Fundus photo.
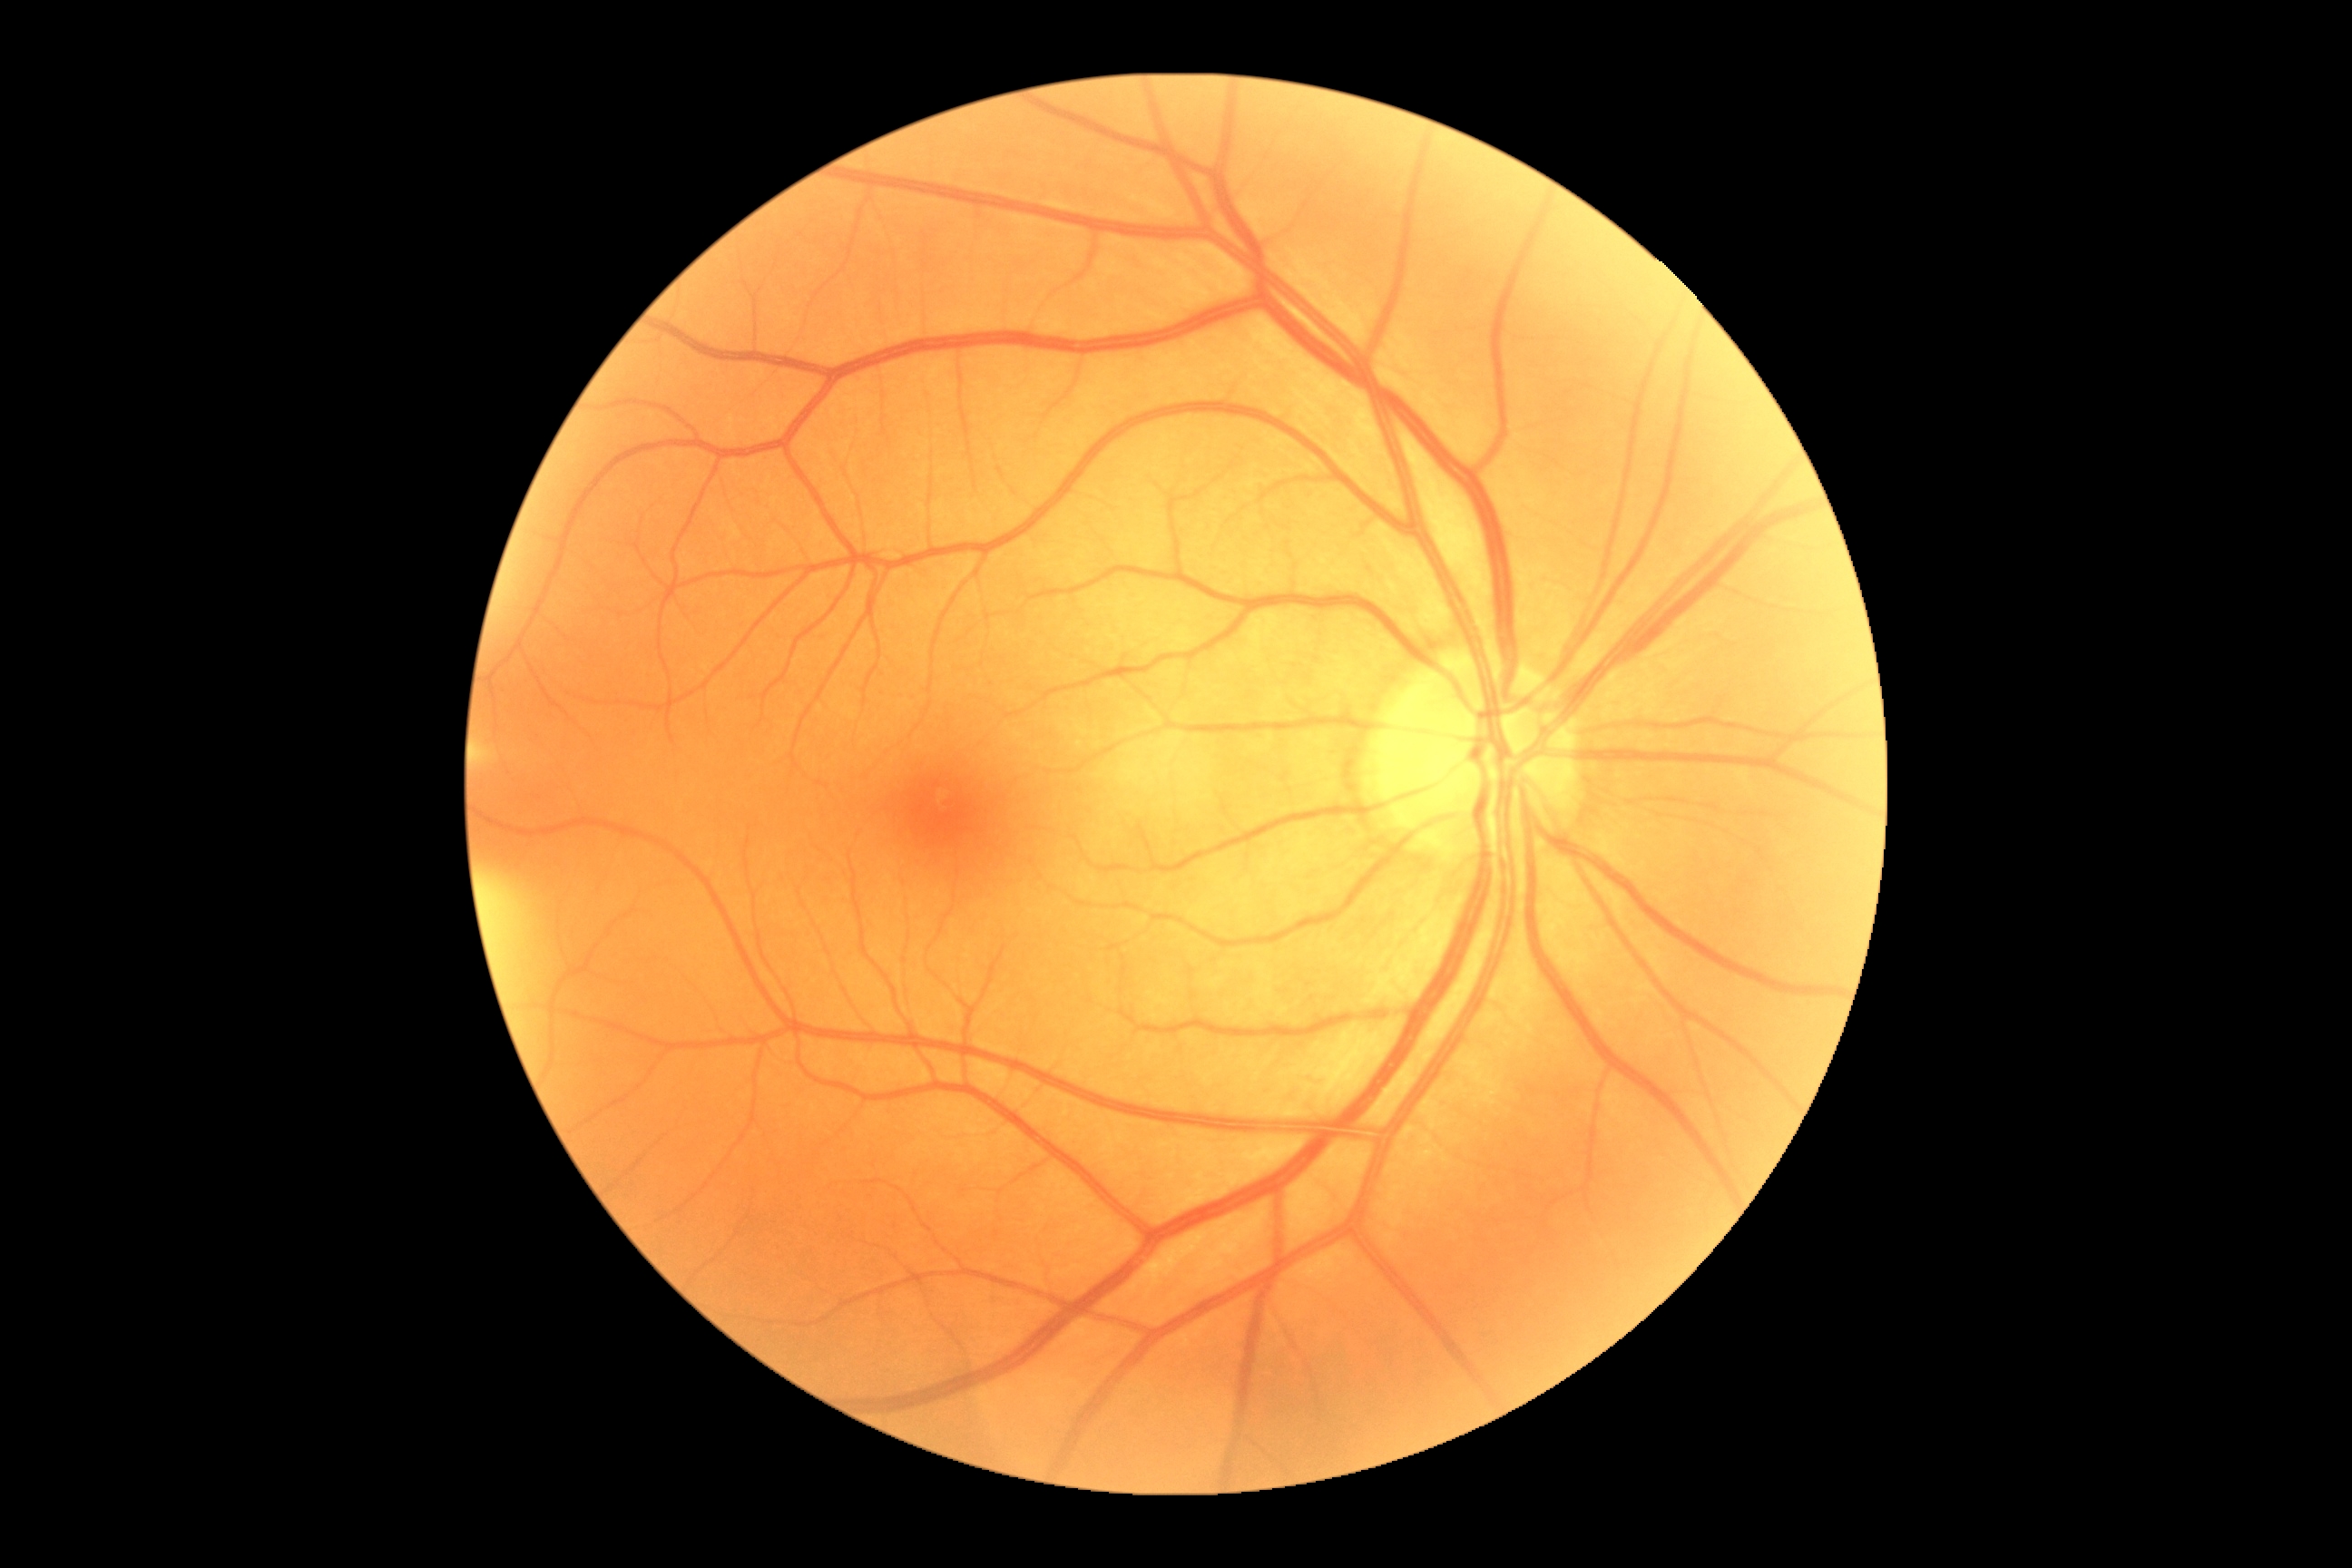
diabetic retinopathy: no apparent diabetic retinopathy (grade 0).